Acquired on the Phoenix ICON · wide-field contact fundus photograph of an infant · 1240x1240px.
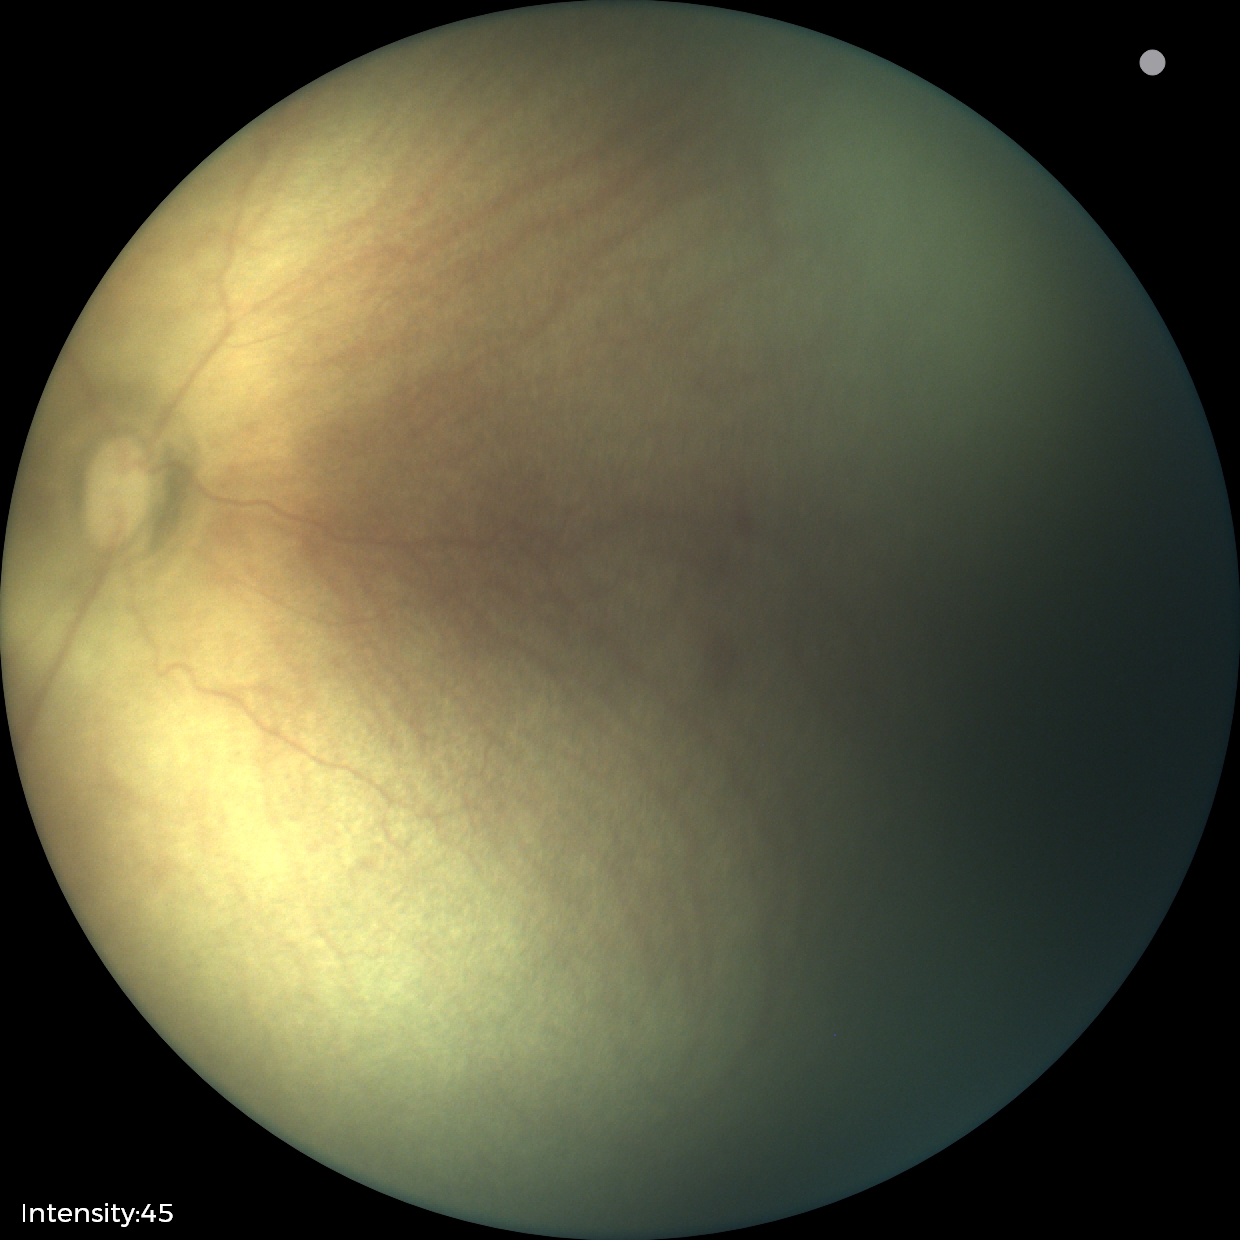
Examination diagnosed as retinopathy of prematurity stage 0. Plus disease absent.